CFP, camera: NIDEK AFC-230, FOV: 45 degrees:
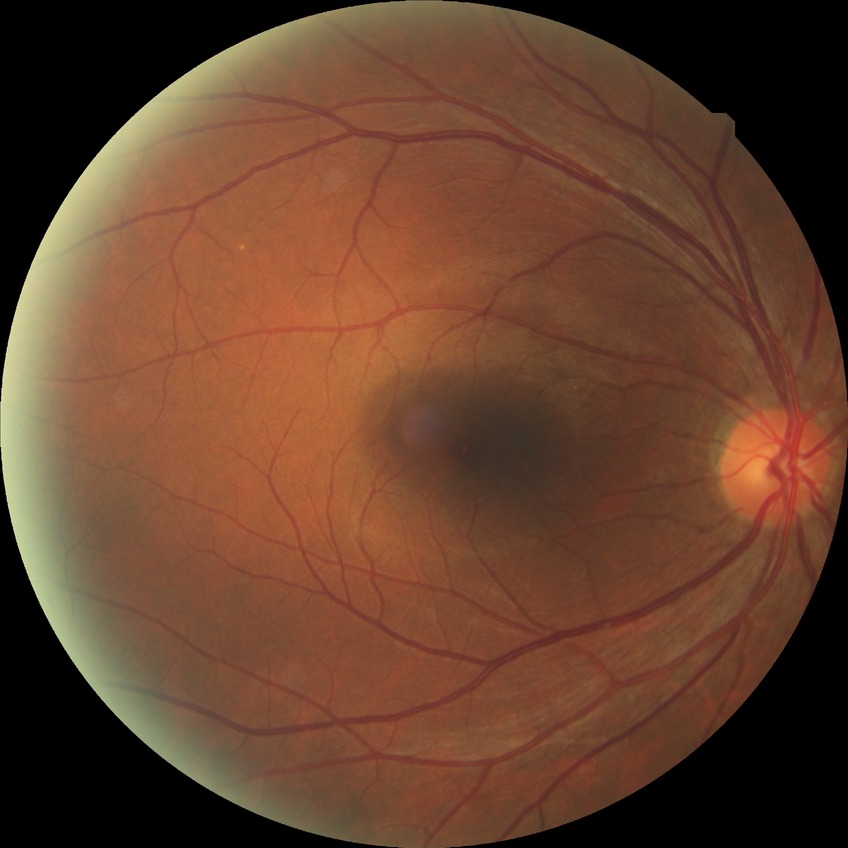

Retinopathy stage is no diabetic retinopathy.